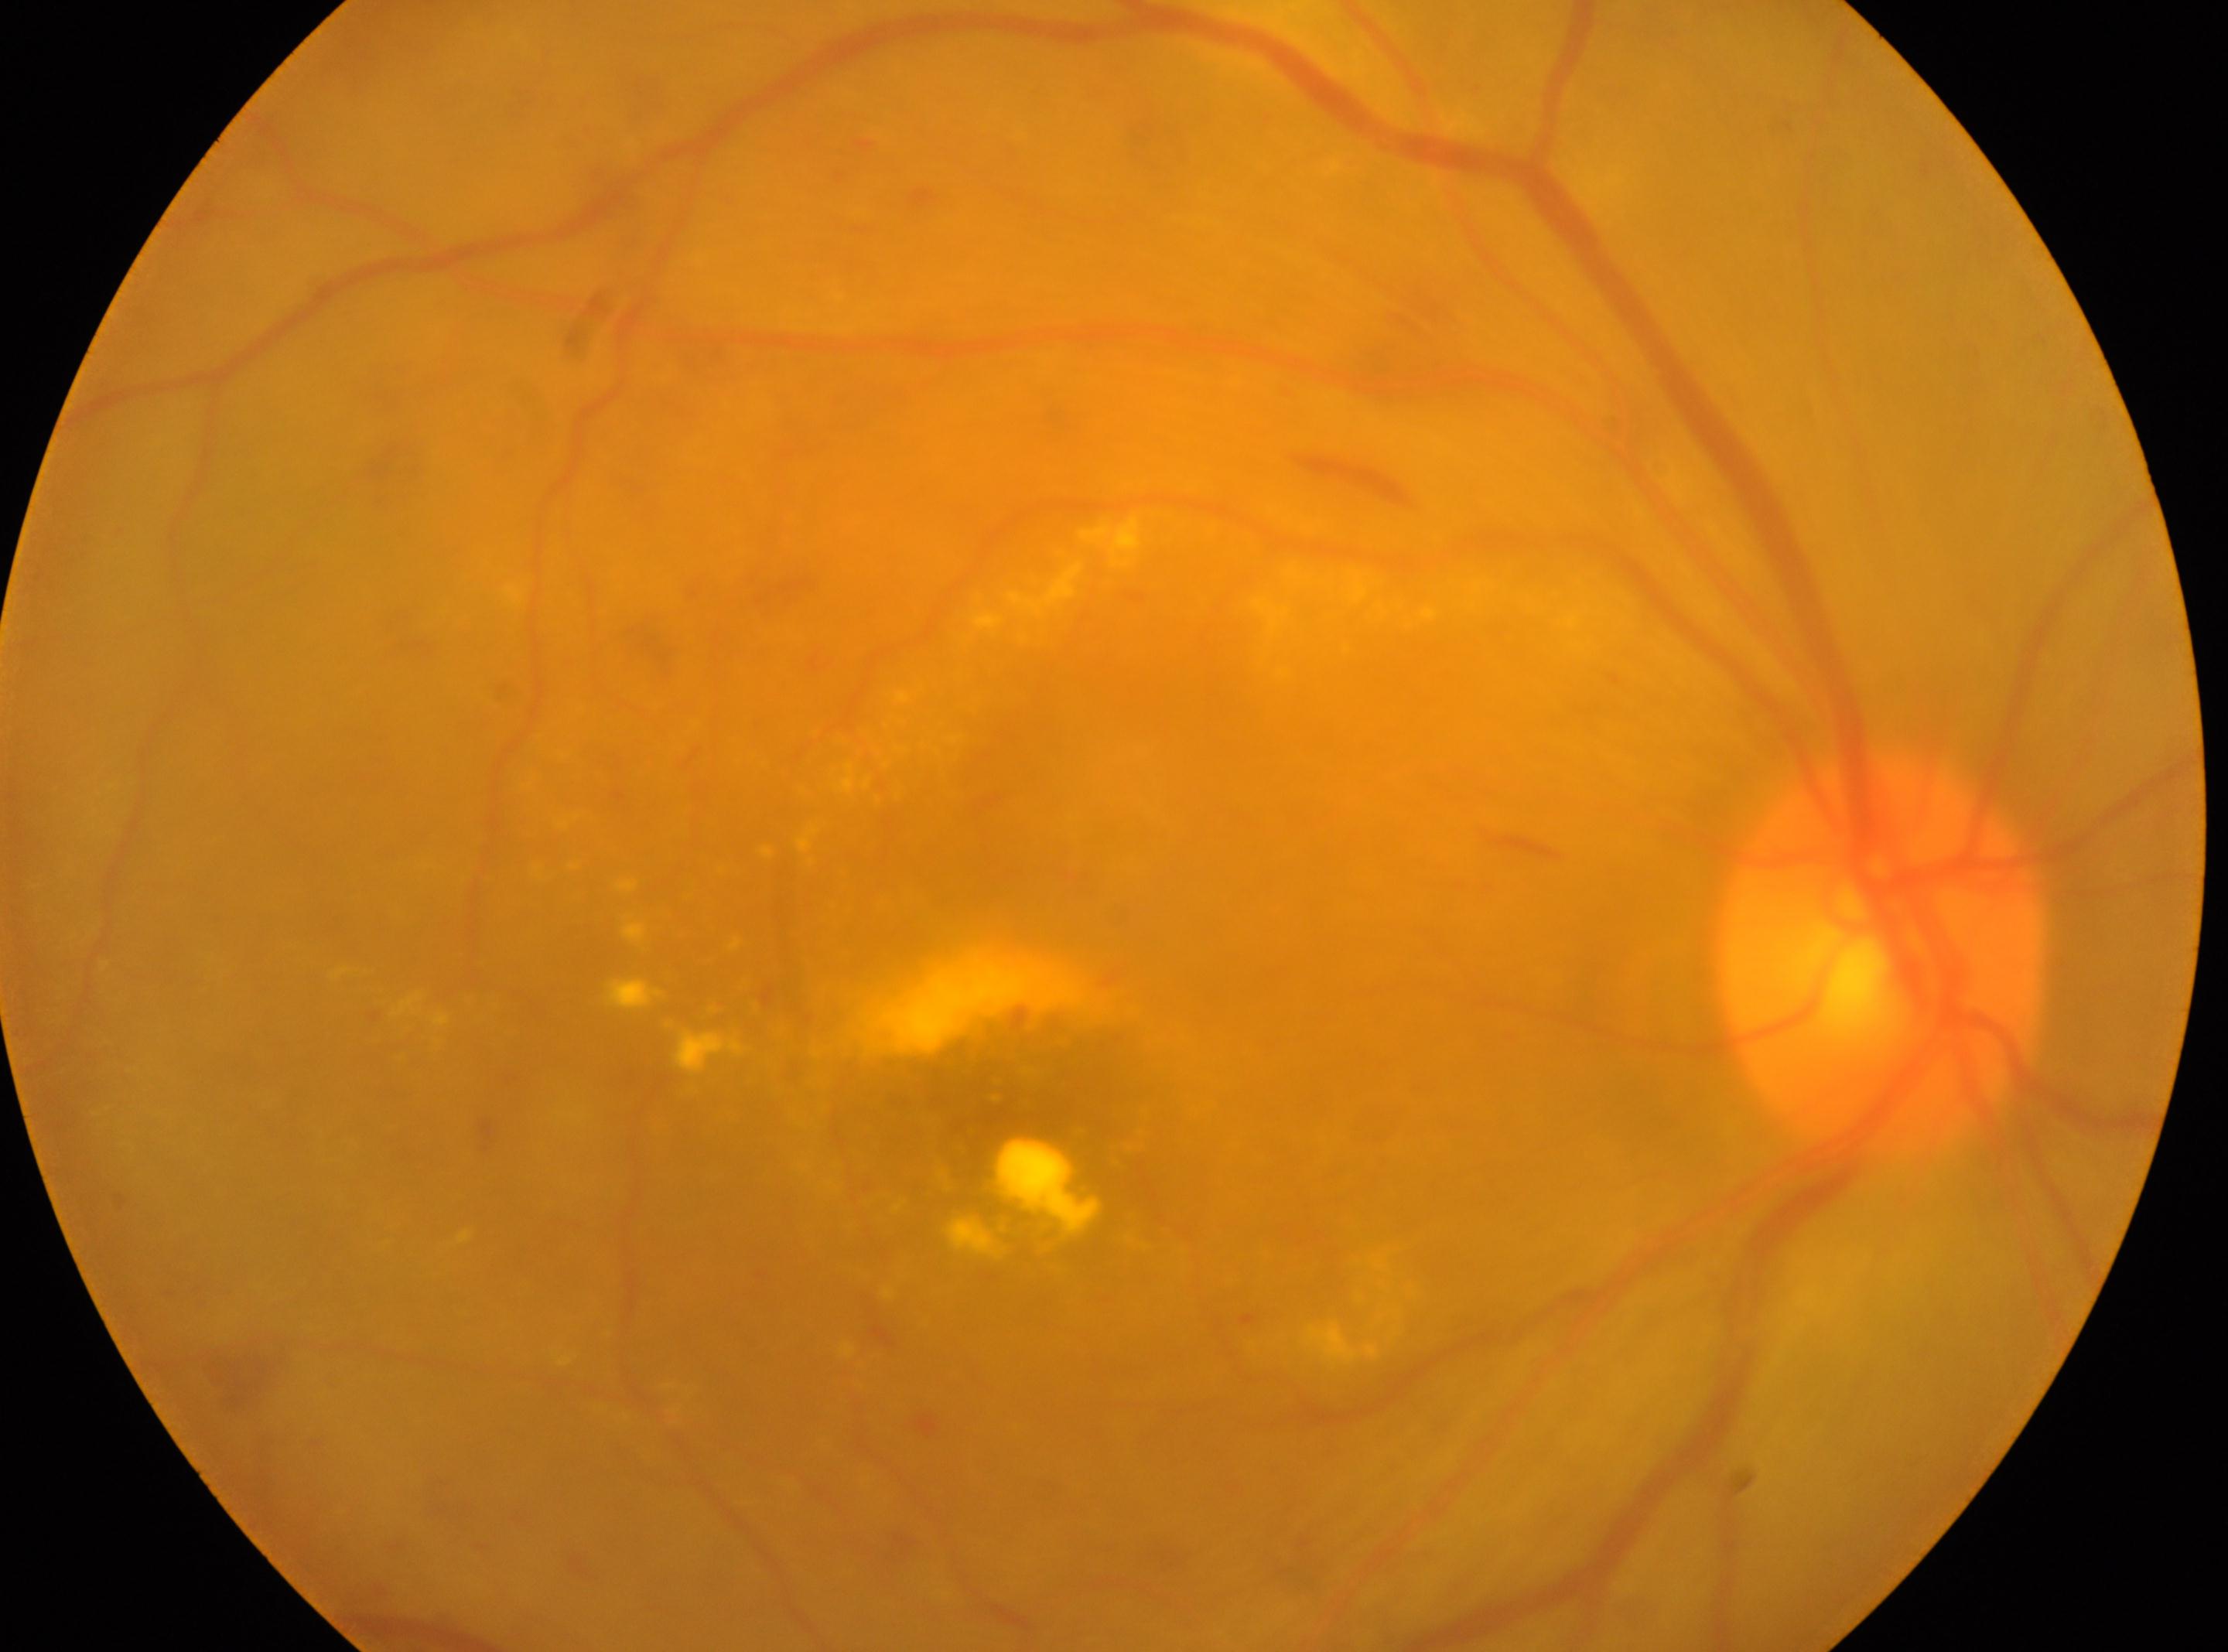

- DR · 2
- laterality · oculus dexter
- fovea center · [1004, 1128]
- optic disc center · [1881, 954]